45-degree field of view: 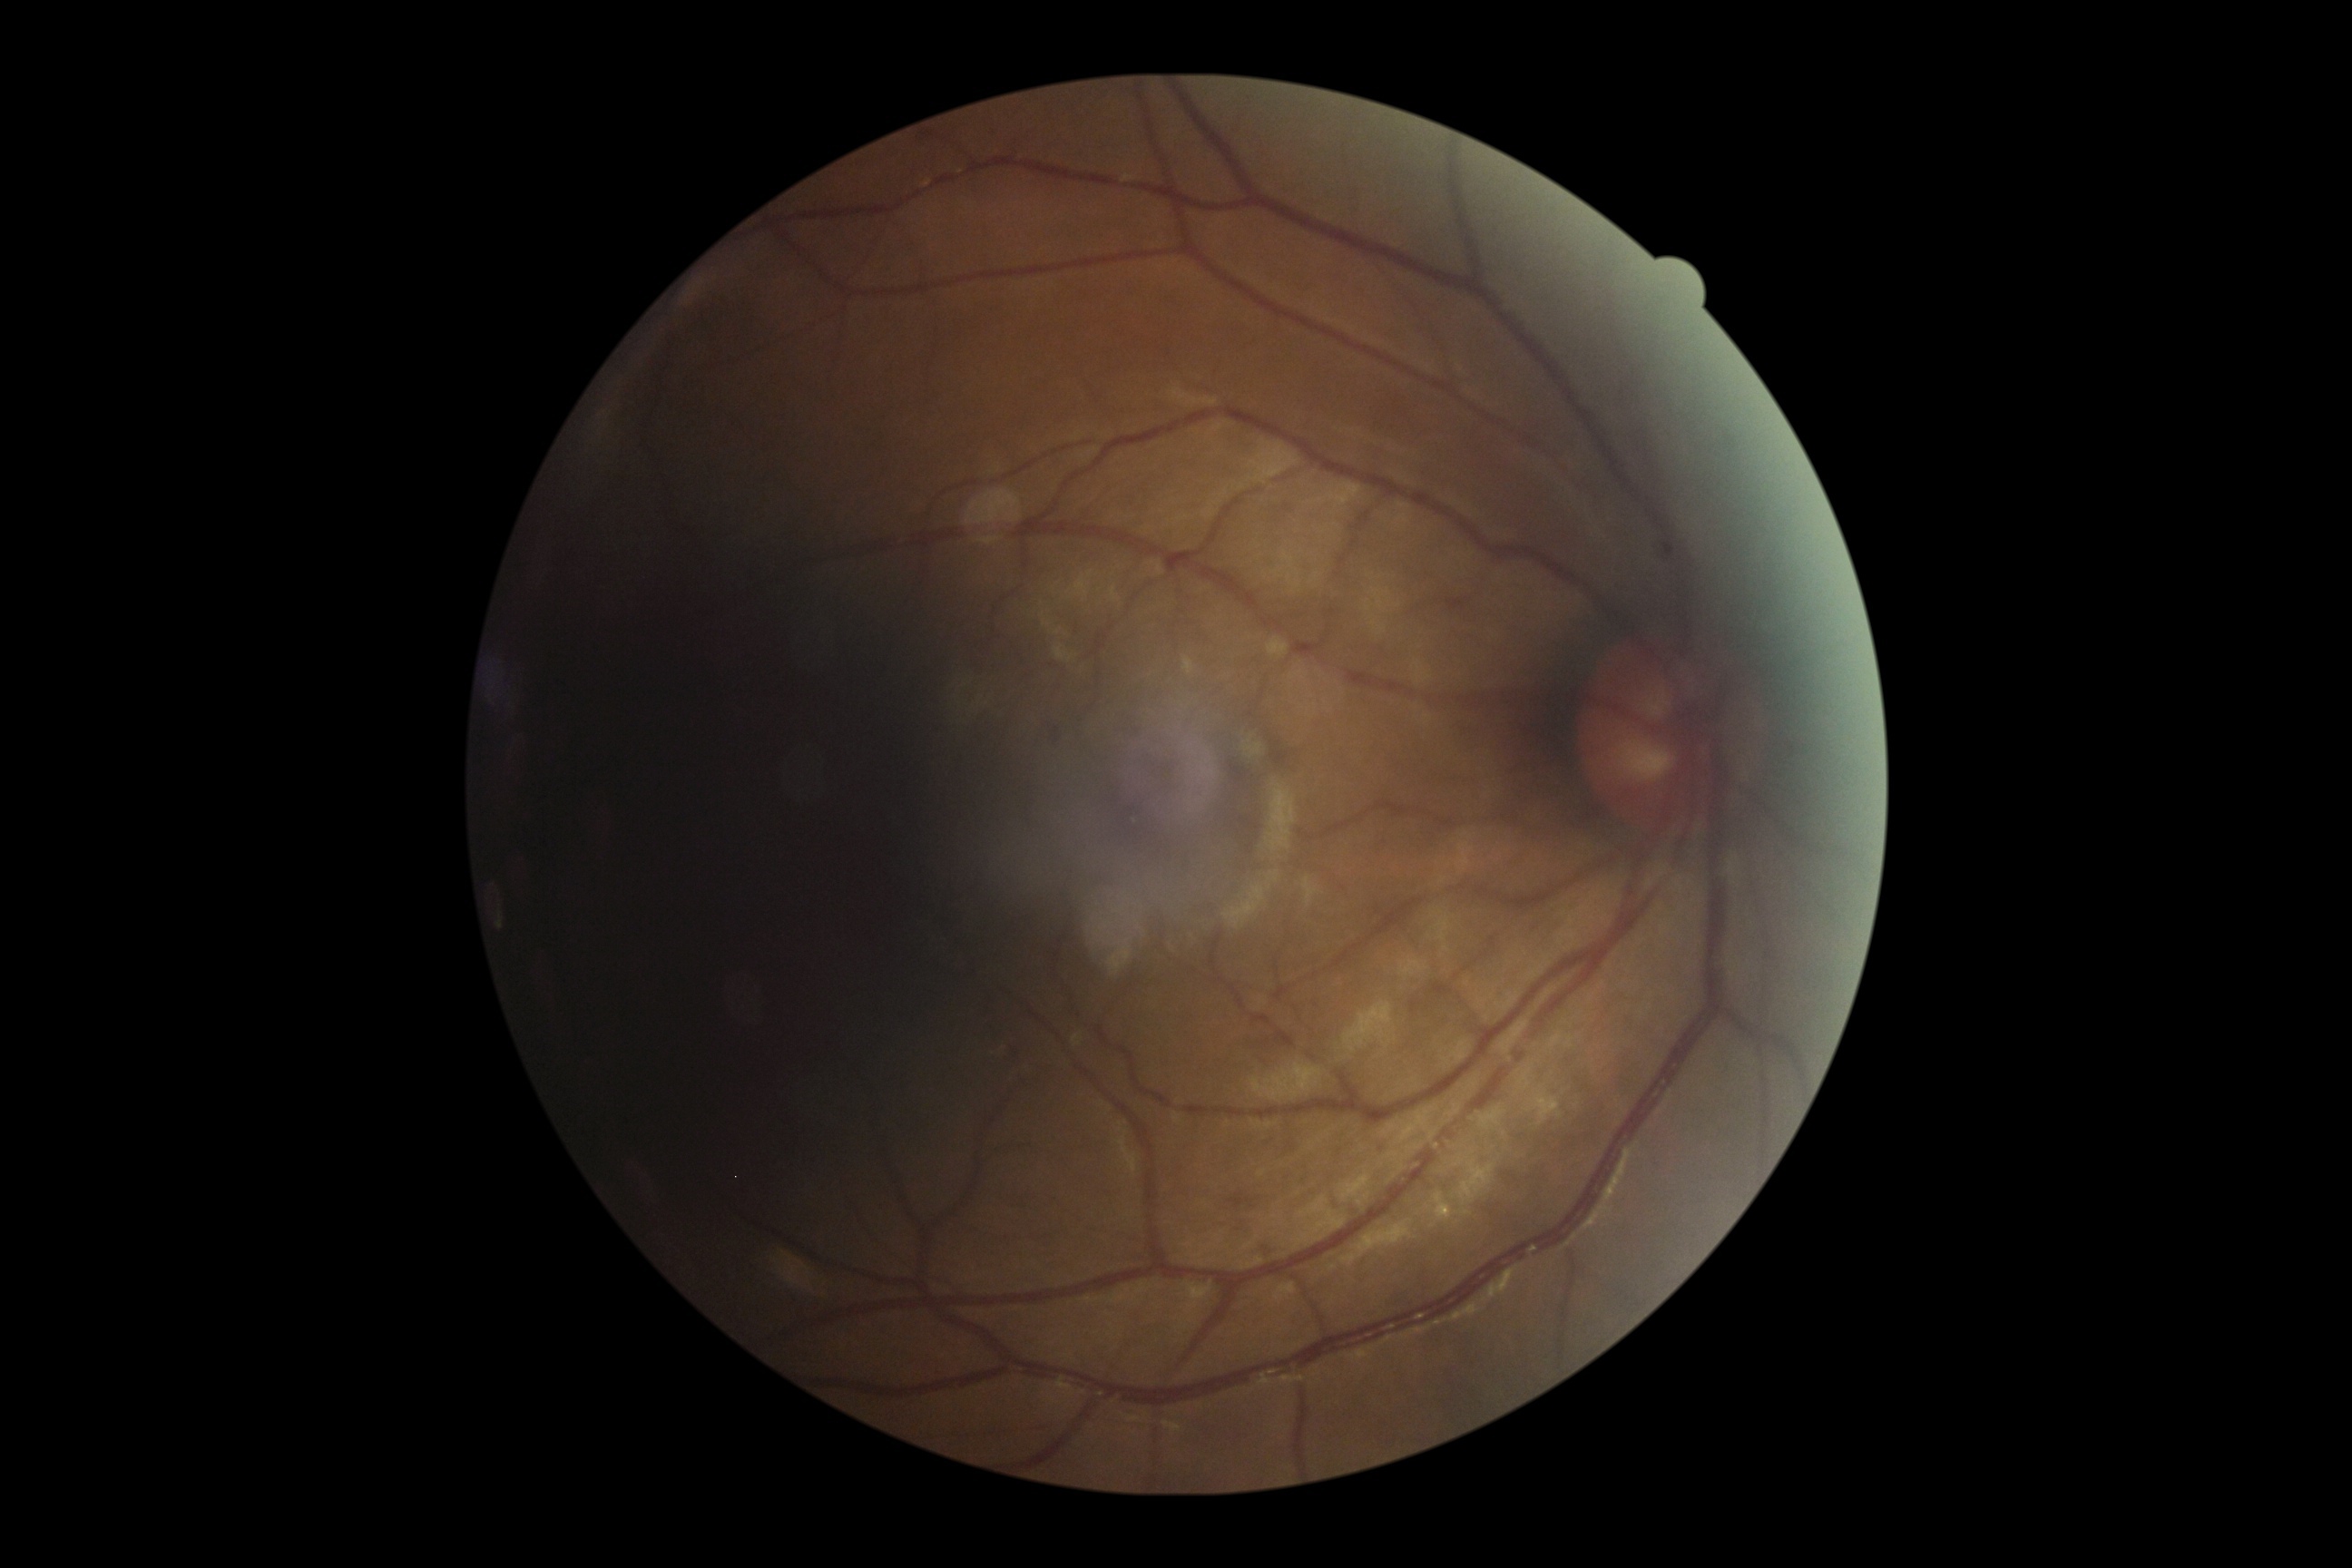

Retinopathy grade: 1 — presence of microaneurysms only.